FOV: 45 degrees.
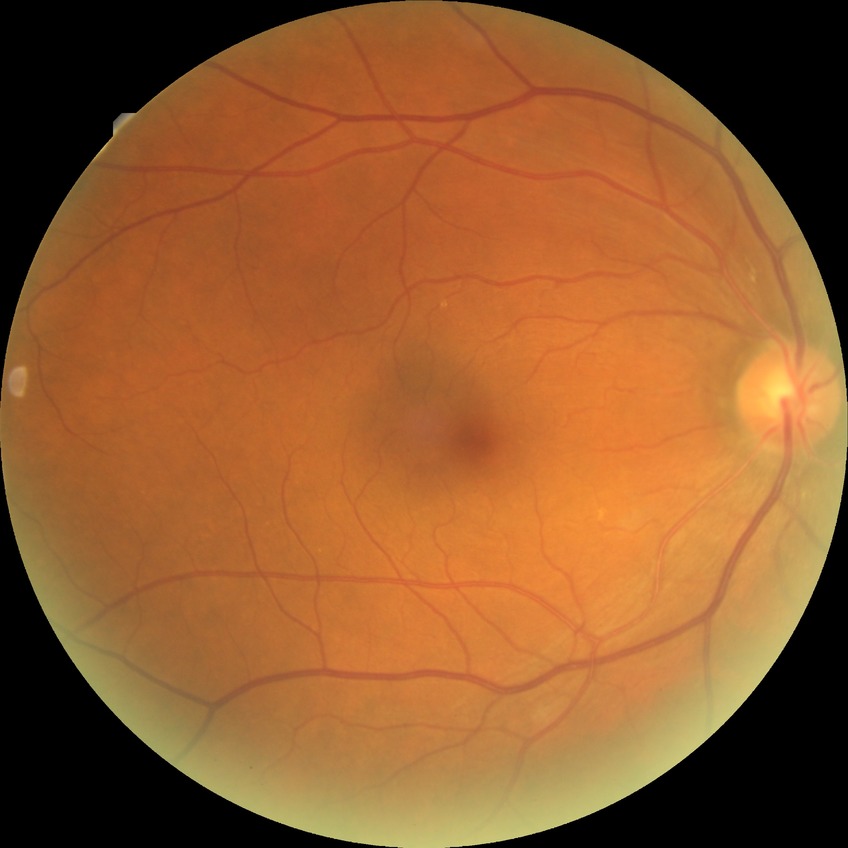

Diabetic retinopathy (DR): NDR (no diabetic retinopathy).